2352 x 1568 pixels; FOV: 45 degrees
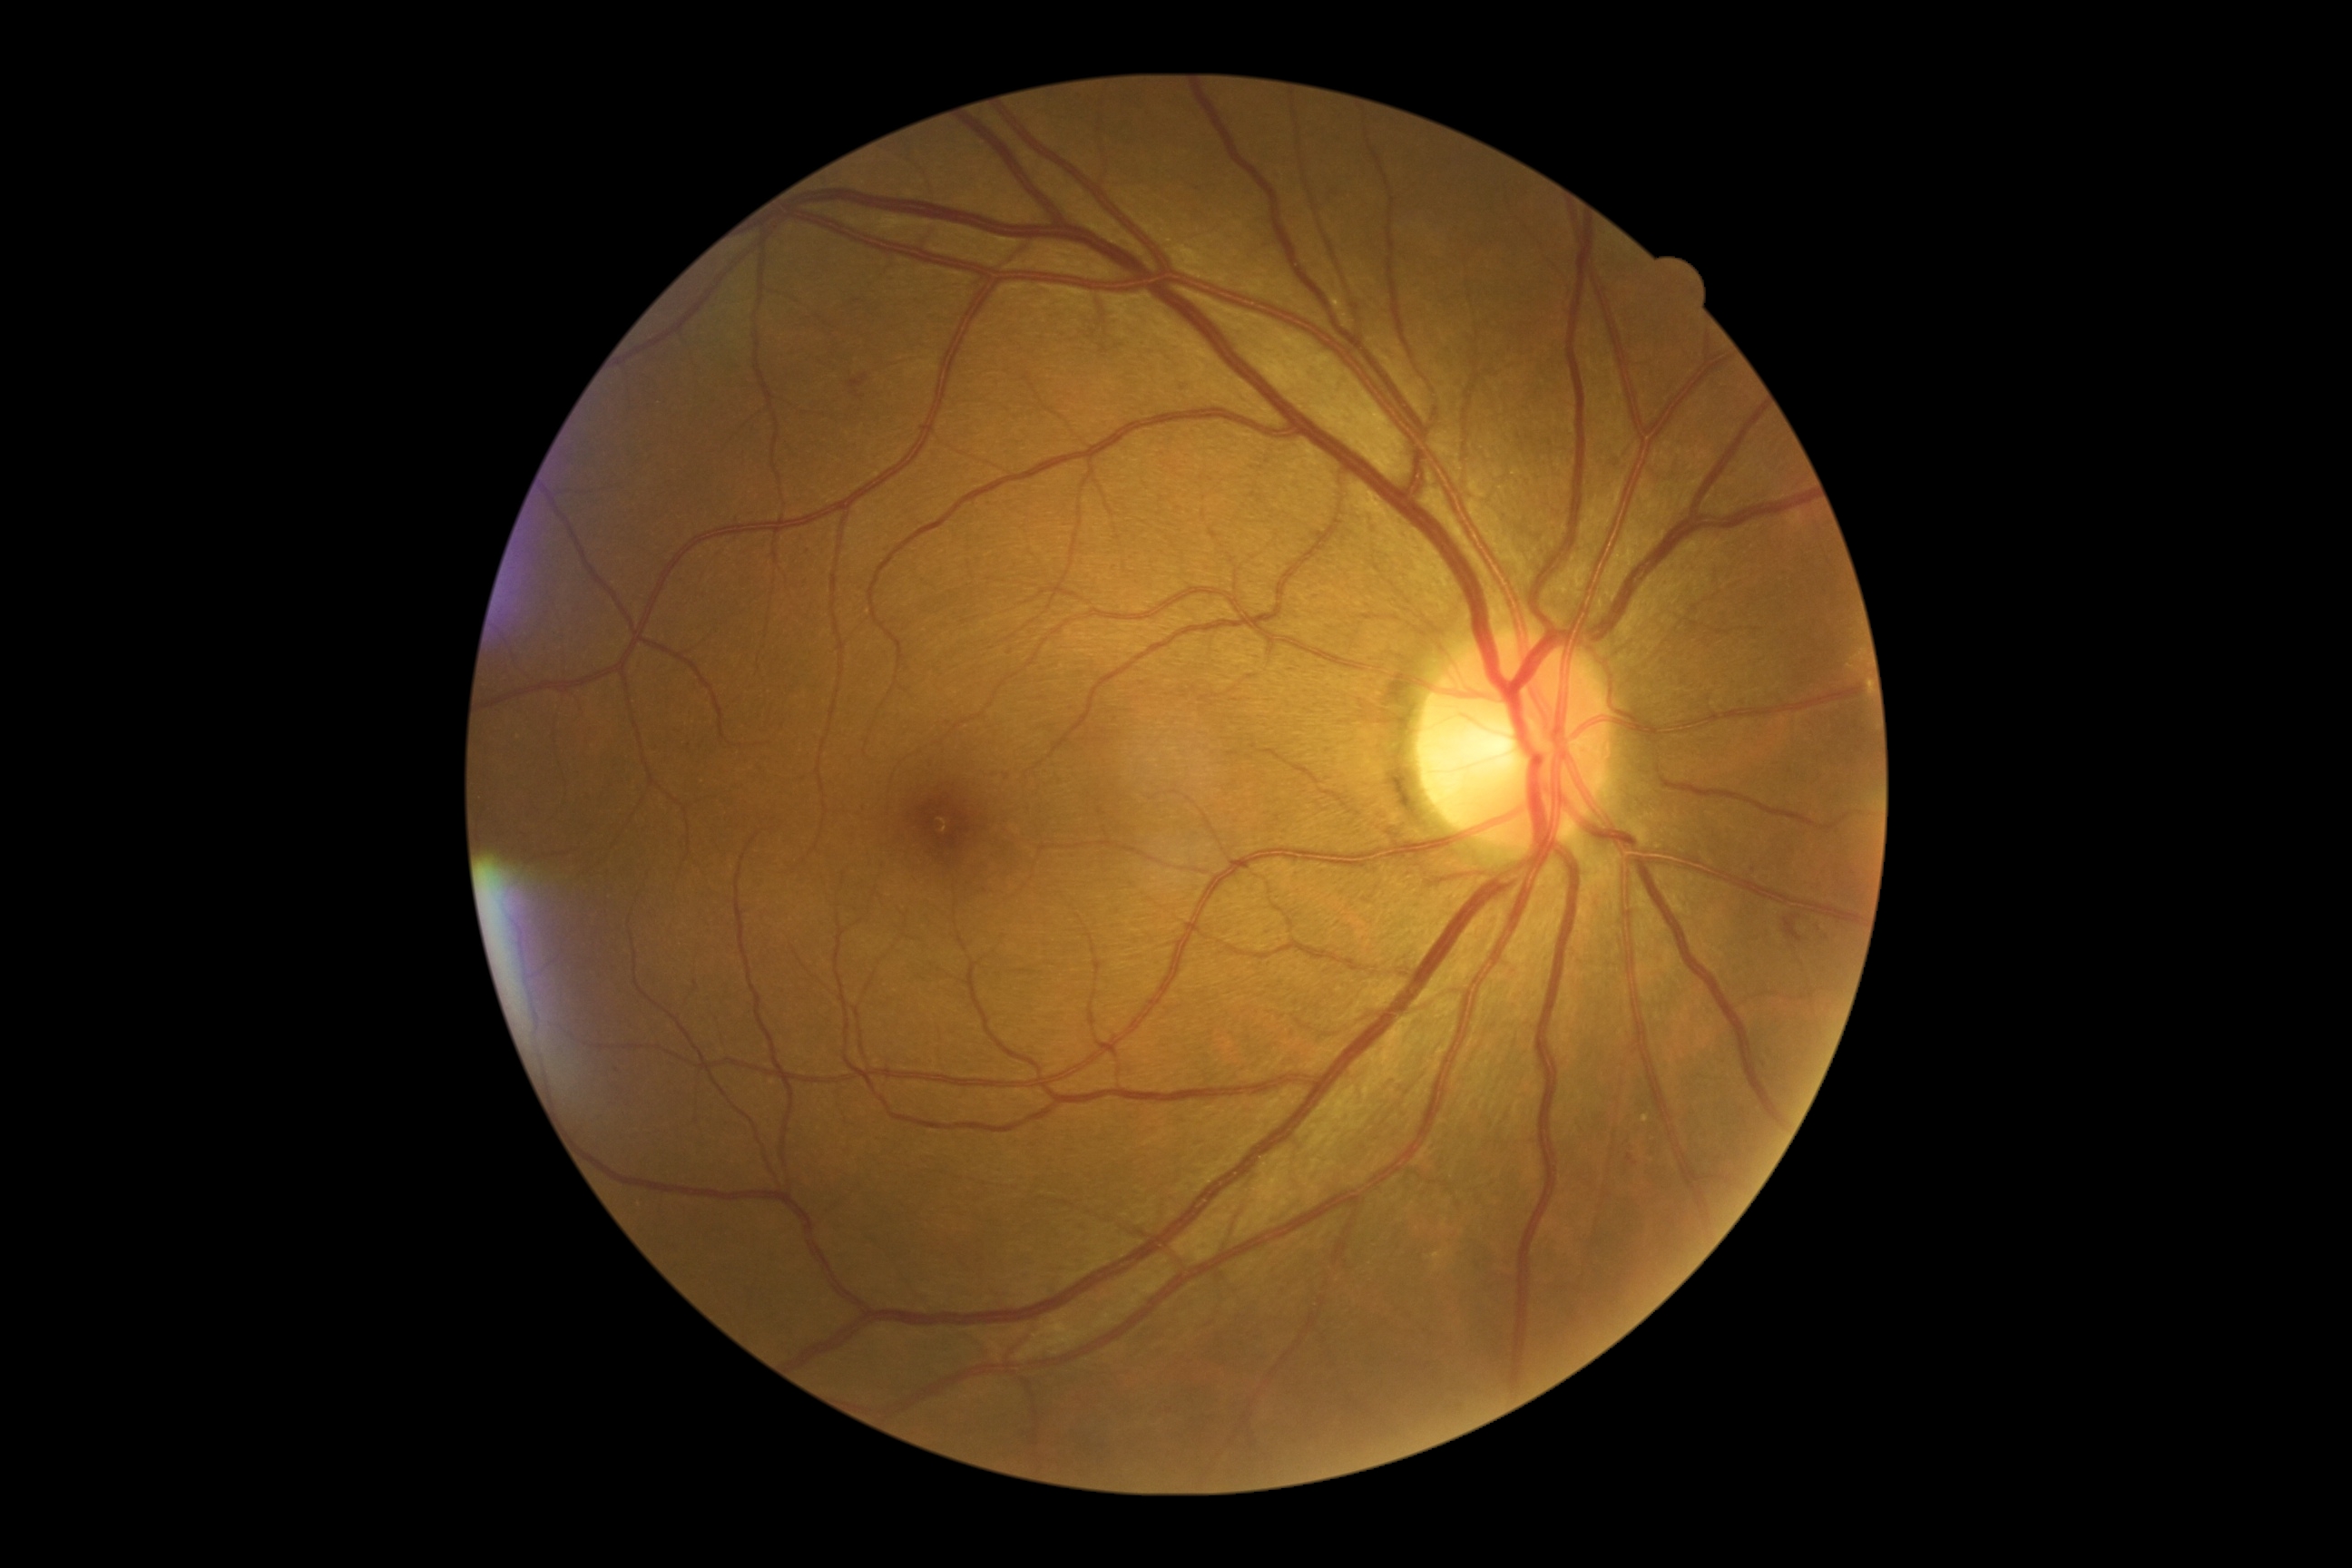

Disease class: non-proliferative diabetic retinopathy. DR is grade 2 (moderate NPDR).